Fundus photo. 45-degree field of view. 2212 by 1659 pixels.
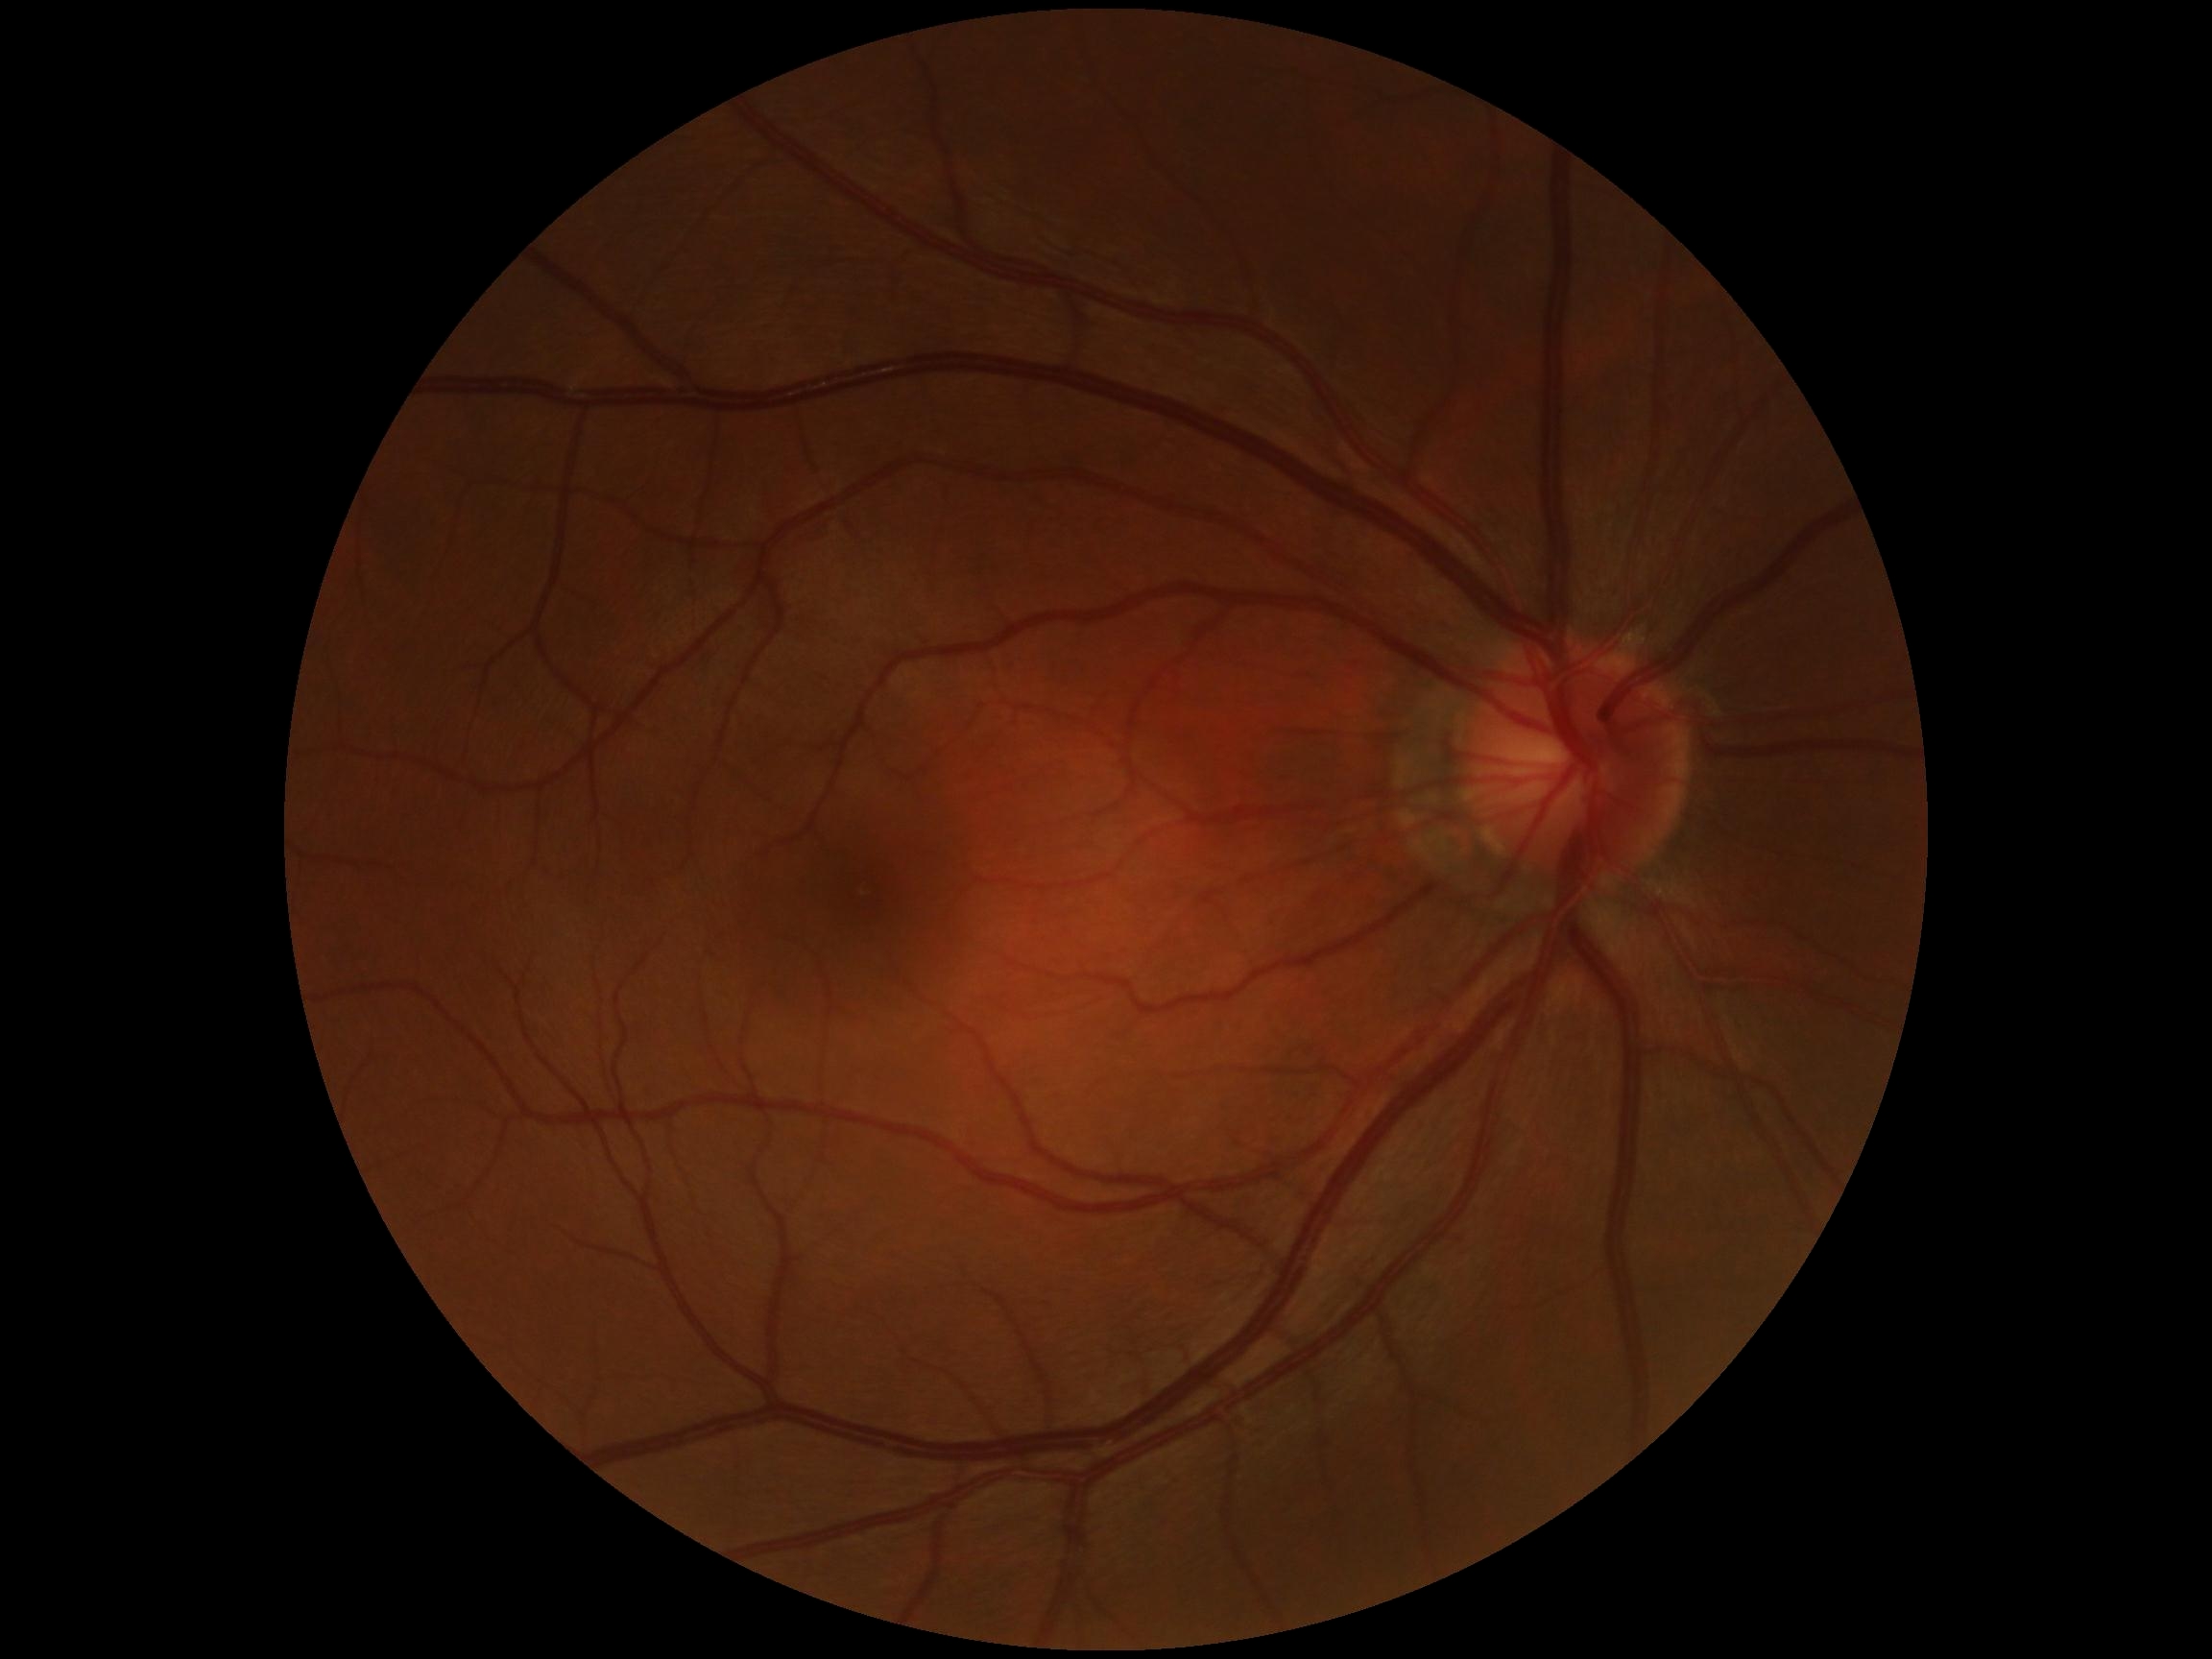 No signs of diabetic retinopathy. Retinopathy is no apparent retinopathy (grade 0).